848 by 848 pixels
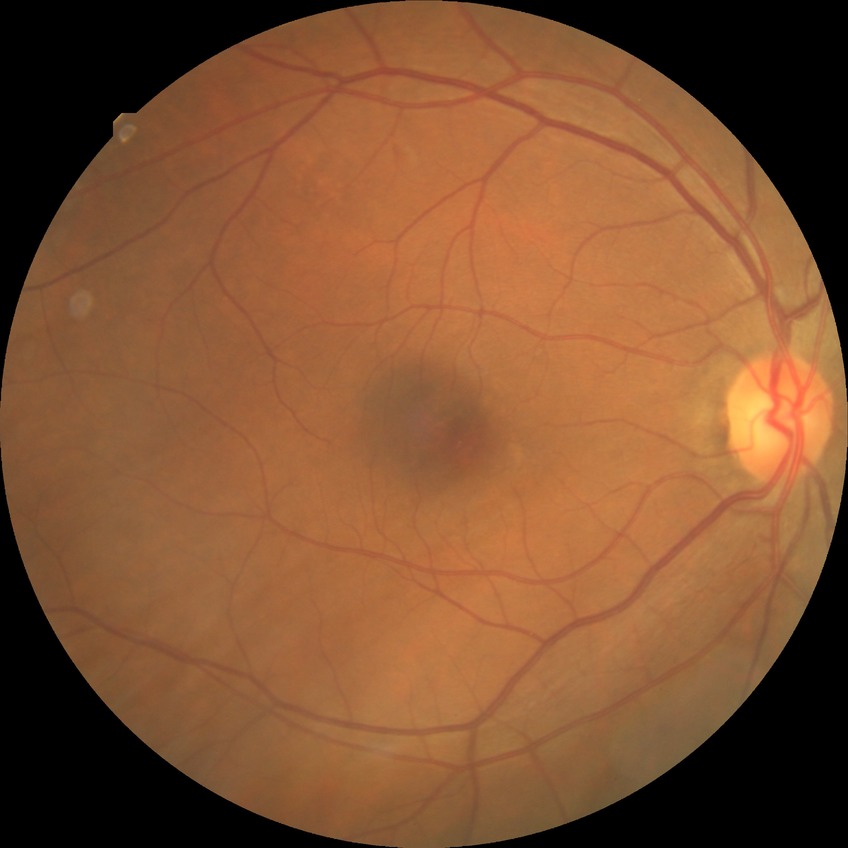

diabetic retinopathy grade@no diabetic retinopathy.